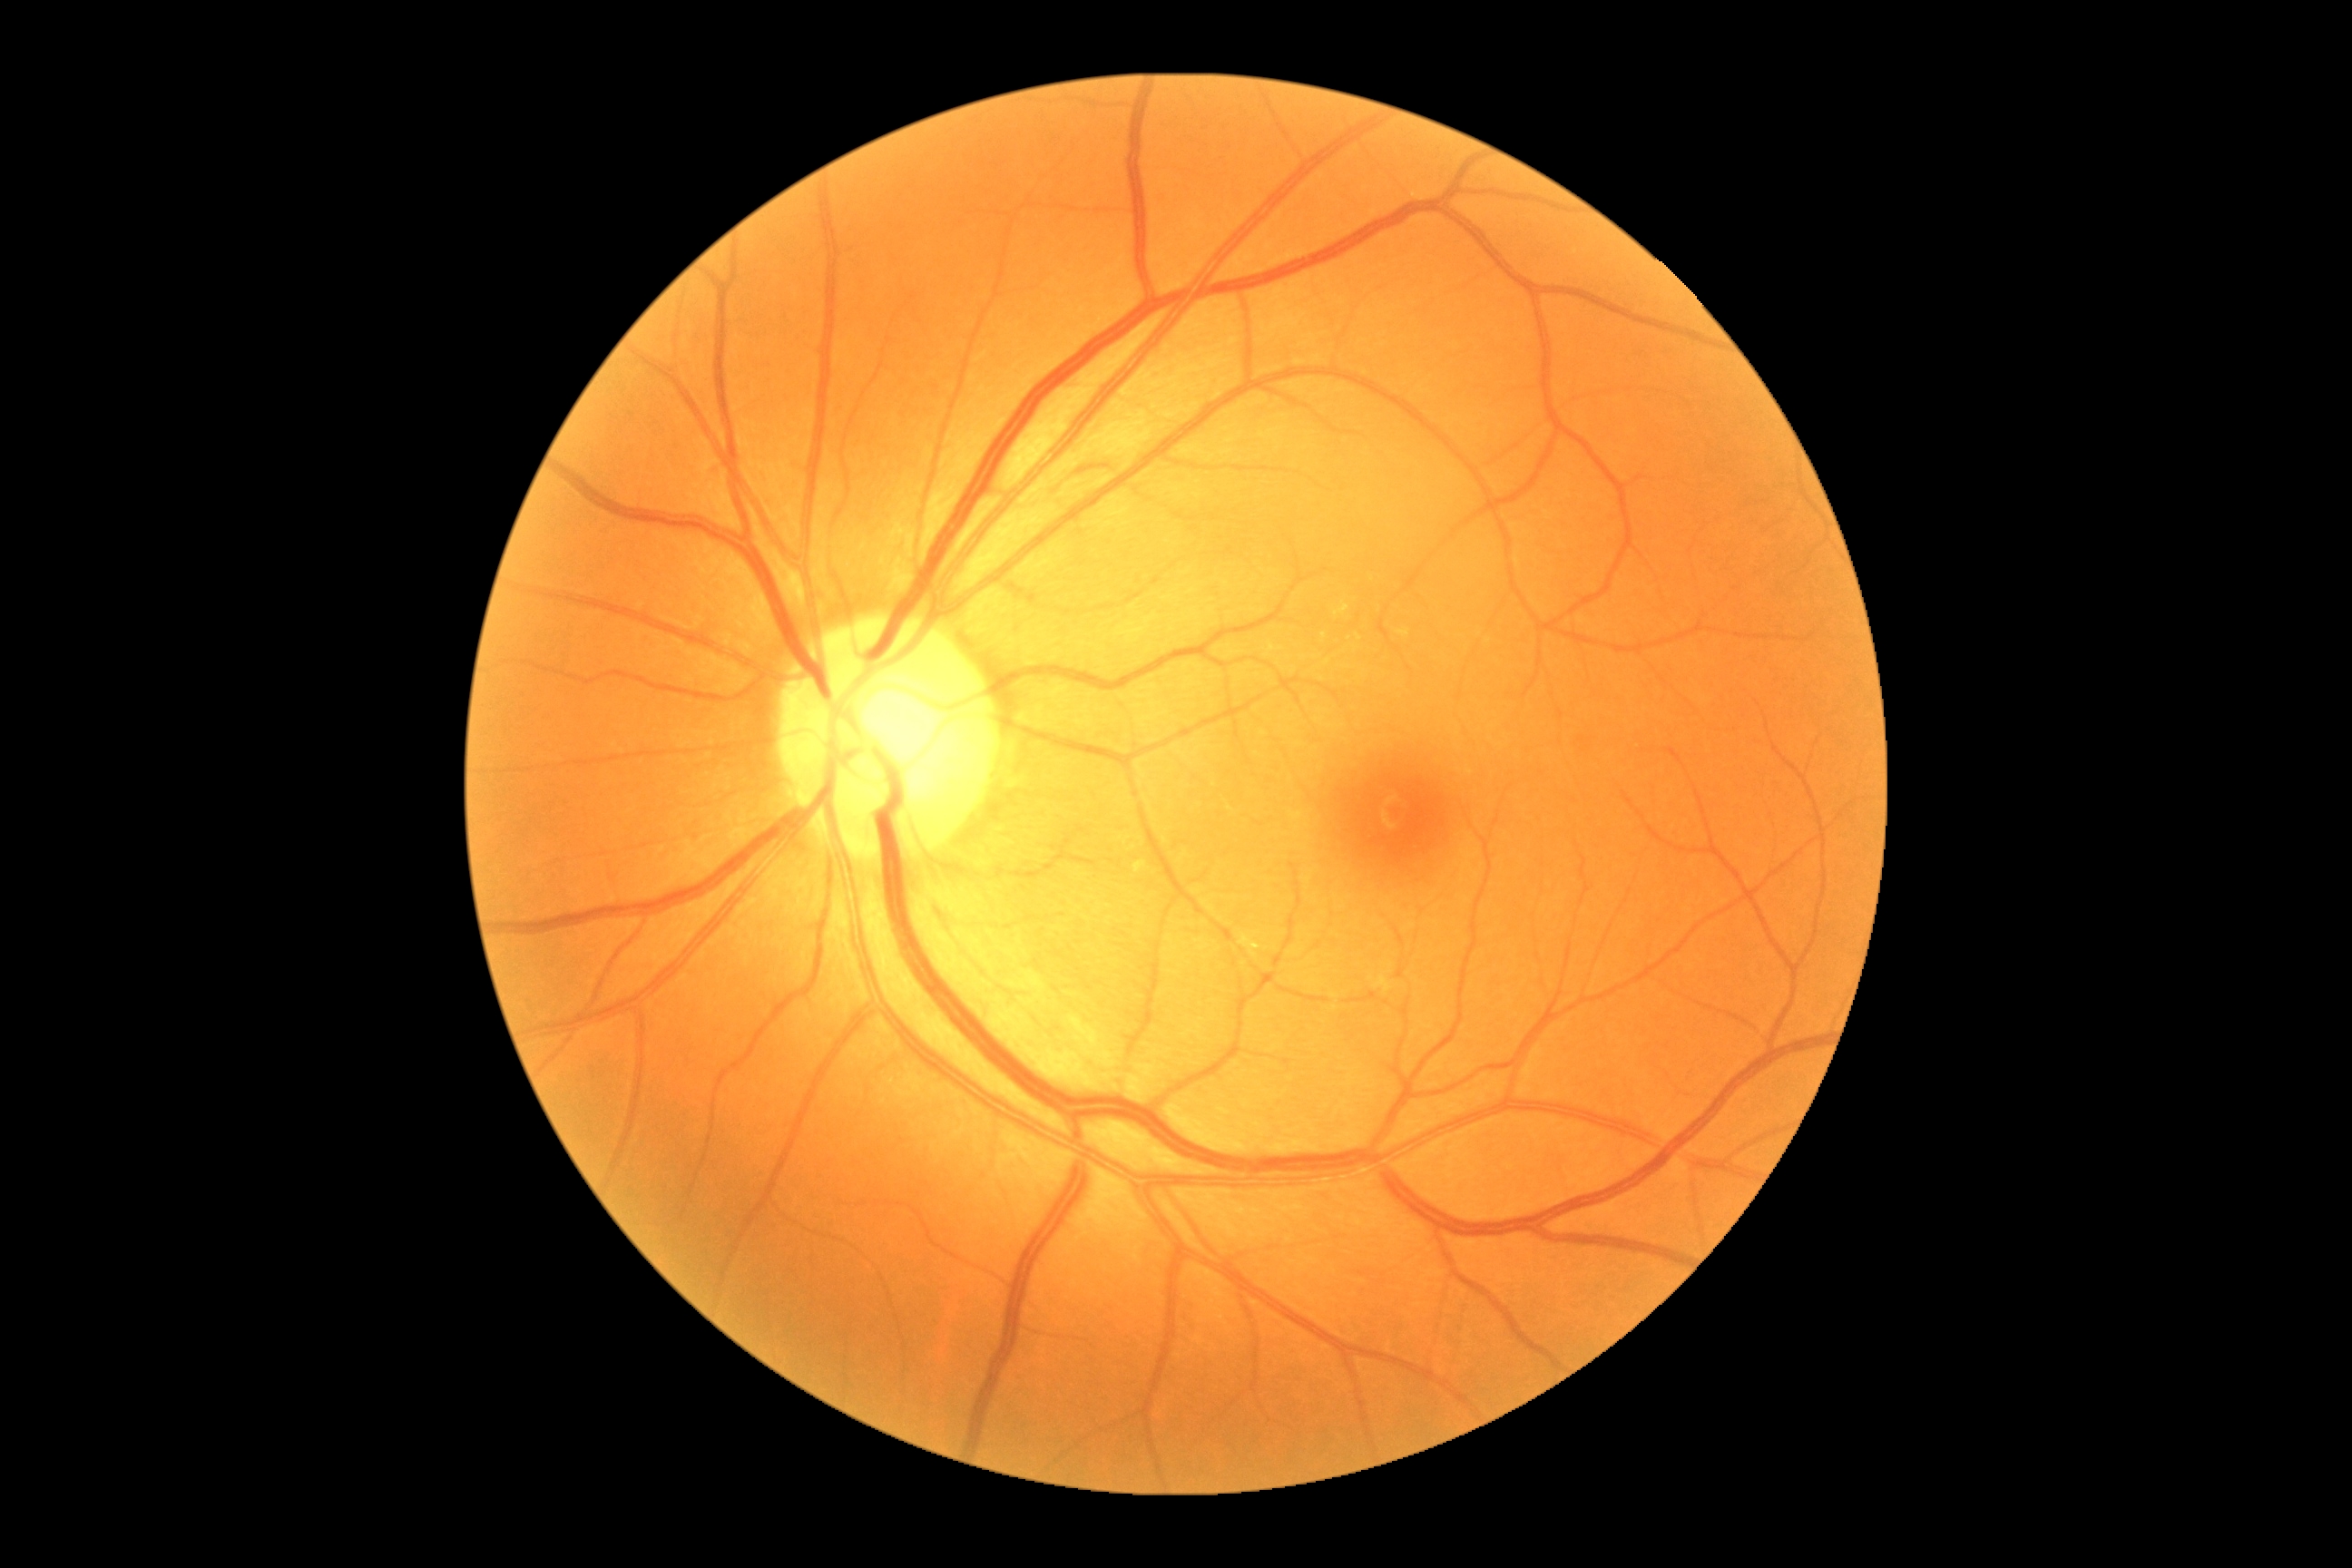 DR severity: grade 0 (no apparent retinopathy). No DR findings.